CFP · FOV: 45 degrees: 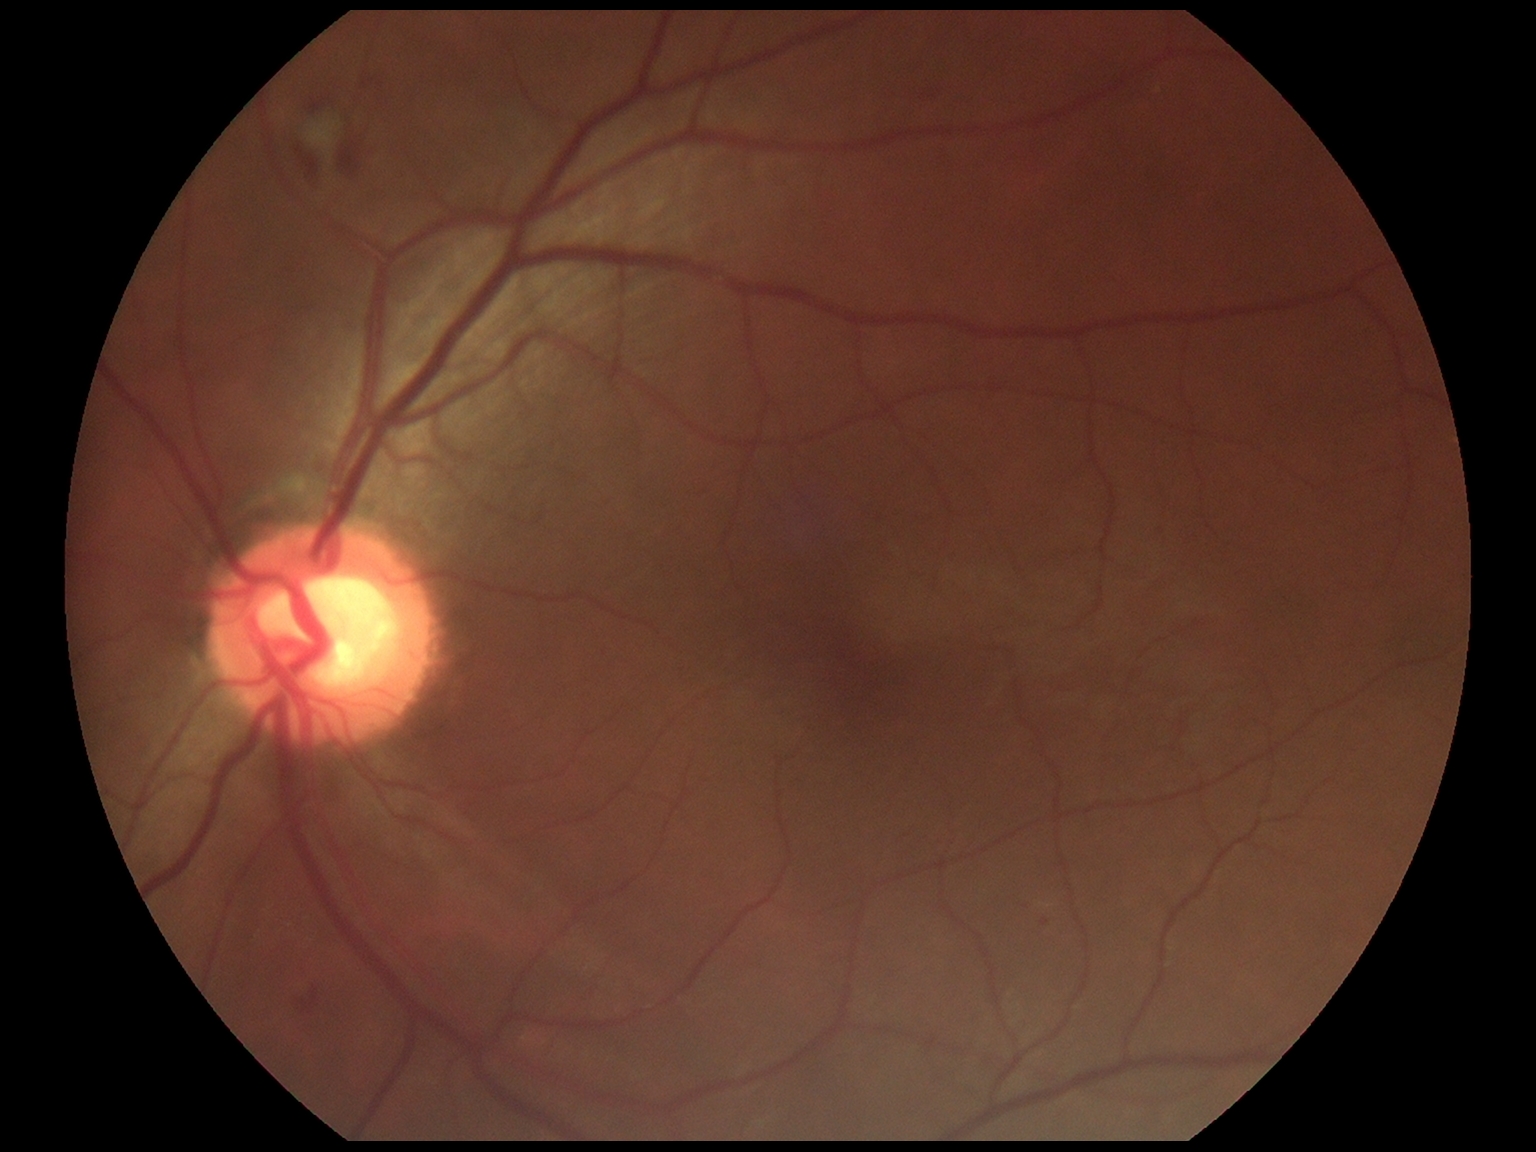

Disease class: non-proliferative diabetic retinopathy. Retinopathy: 2/4.